100° field of view (Phoenix ICON). Wide-field fundus image from infant ROP screening: 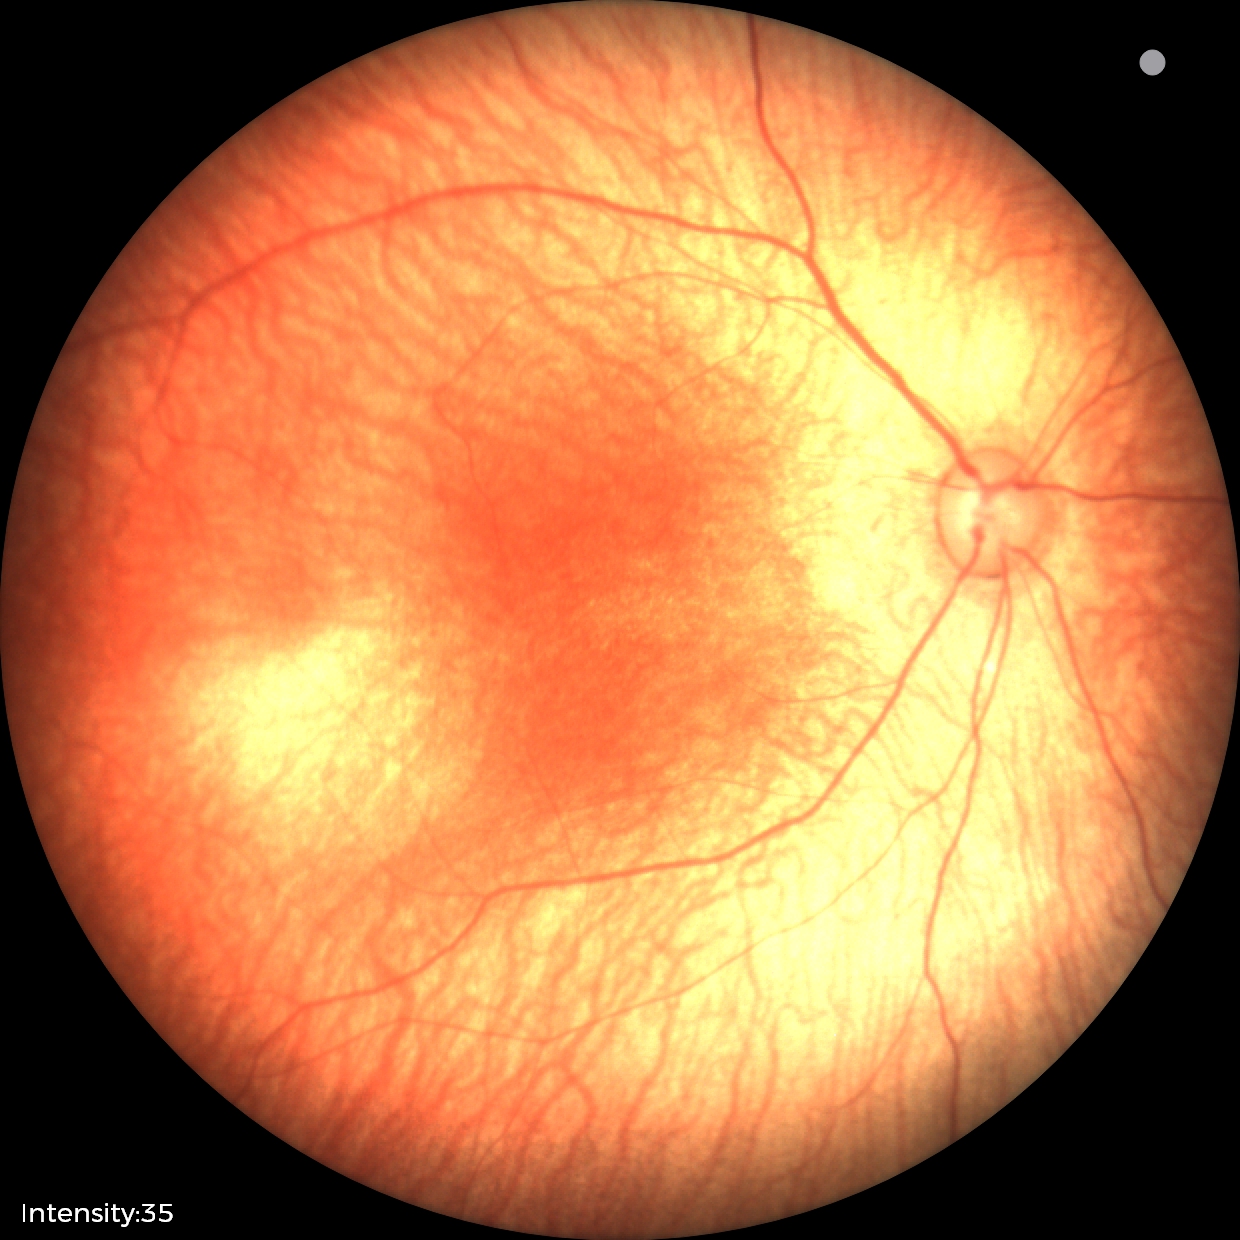 Screening examination diagnosed as physiological.